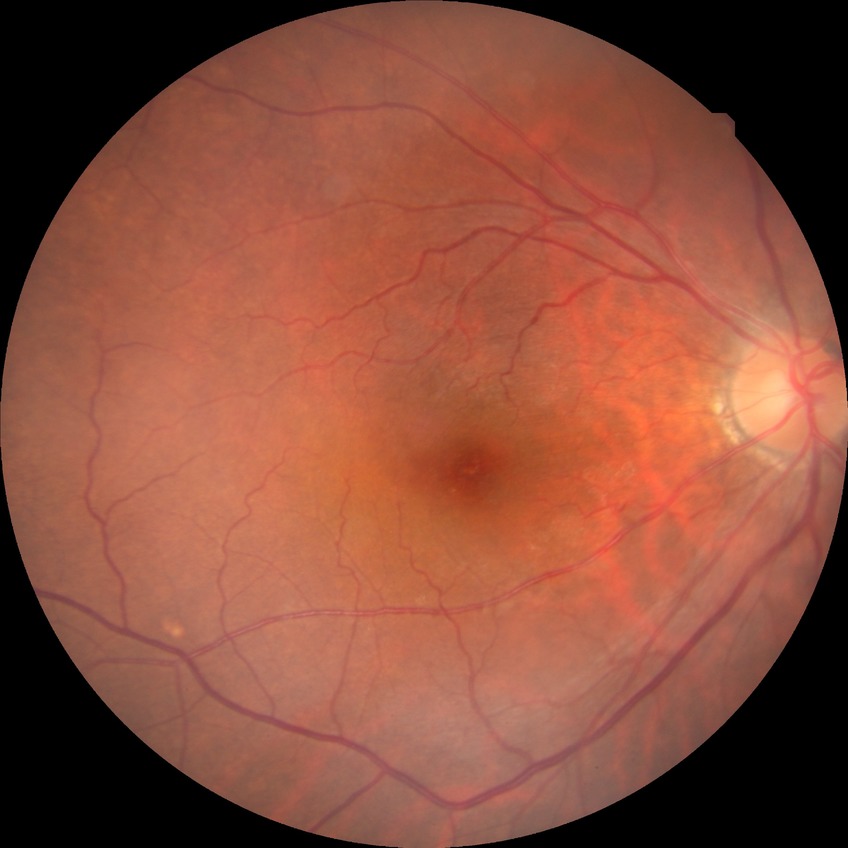 No DR findings. DR stage: NDR.